NIDEK AFC-230 fundus camera. 848x848. Modified Davis classification. 45 degree fundus photograph: 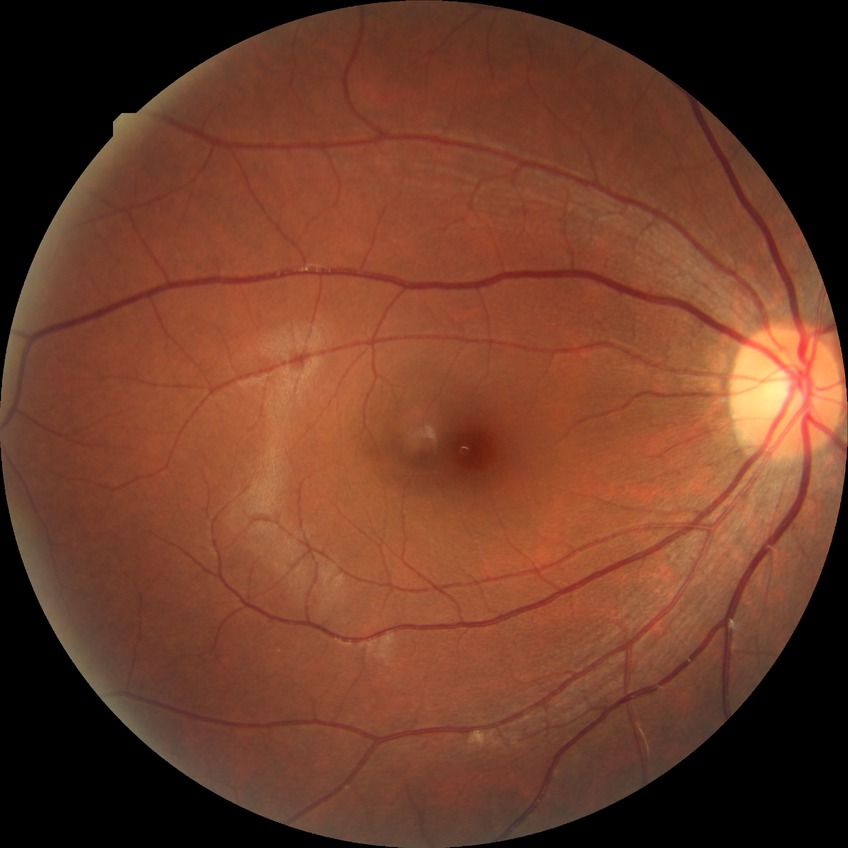
{
  "davis_grade": "NDR (no diabetic retinopathy)"
}